848 by 848 pixels.
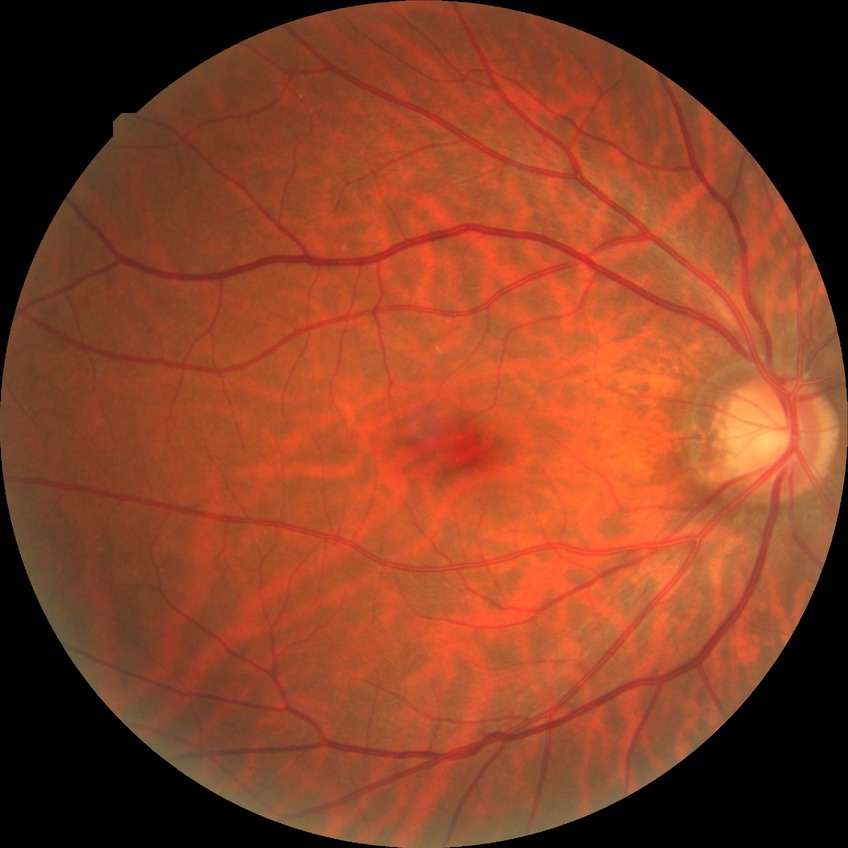
modified Davis grading: no diabetic retinopathy.